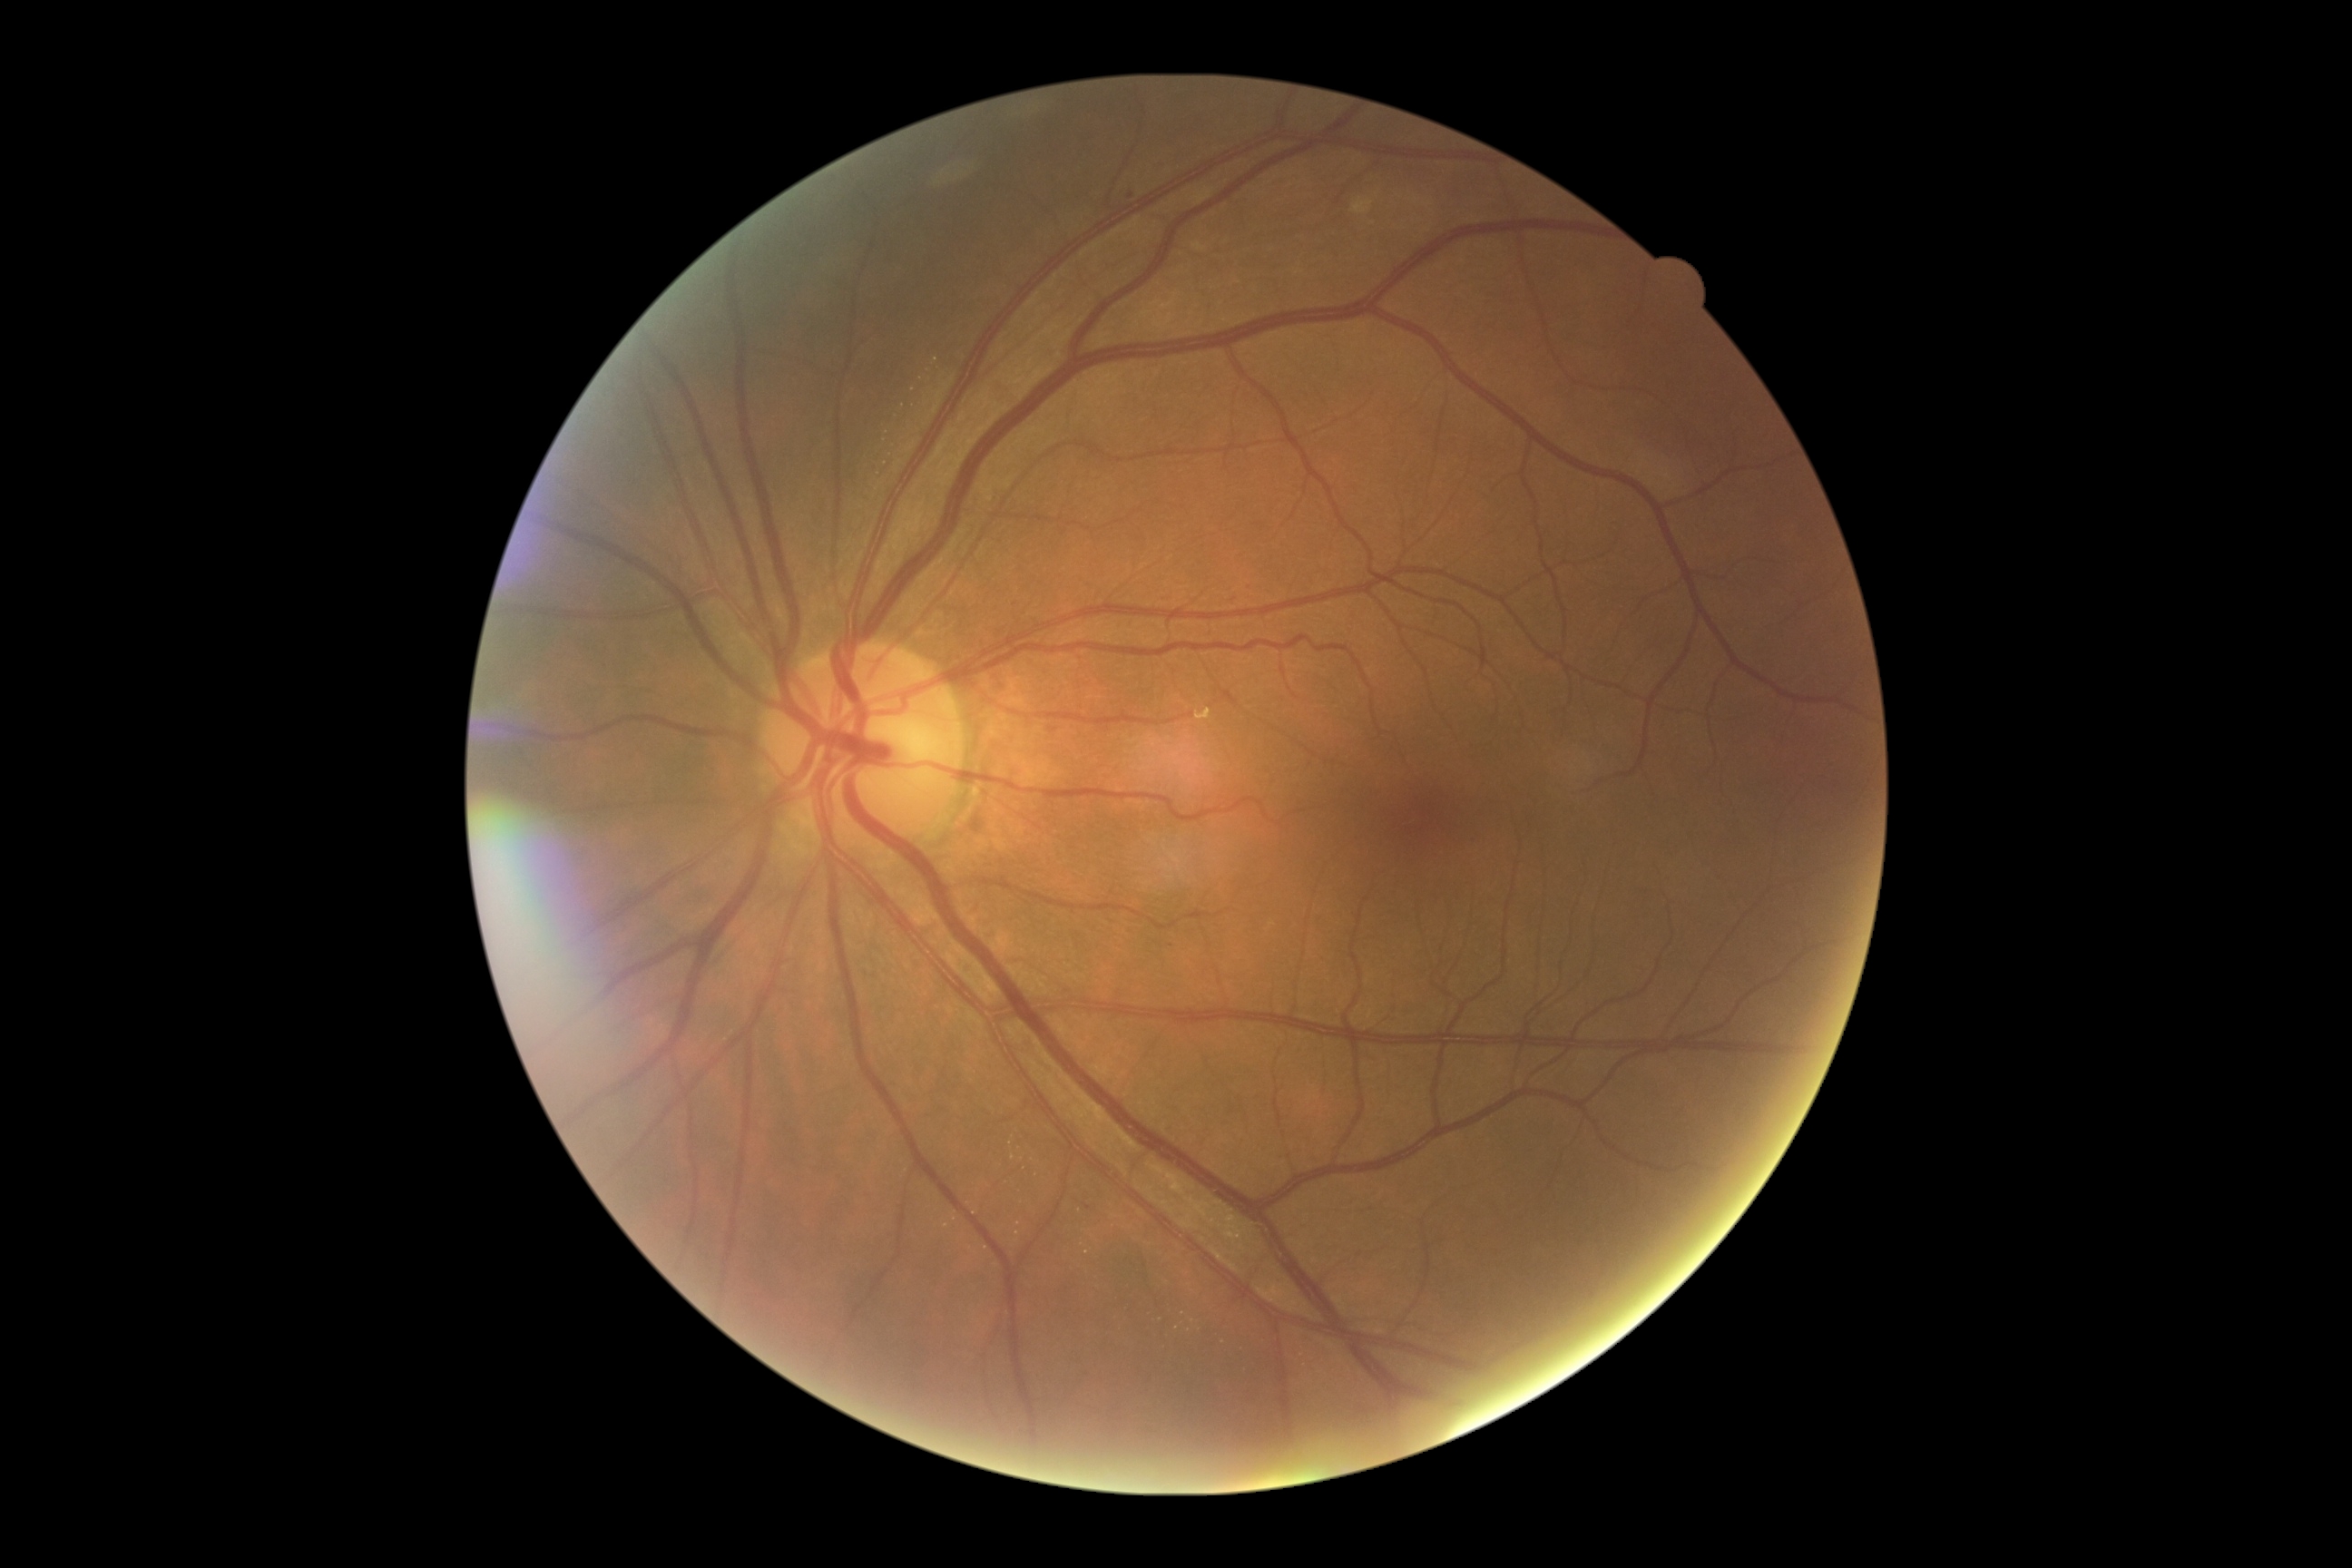
DR = 1.